848 x 848 pixels. Camera: NIDEK AFC-230. Retinal fundus photograph
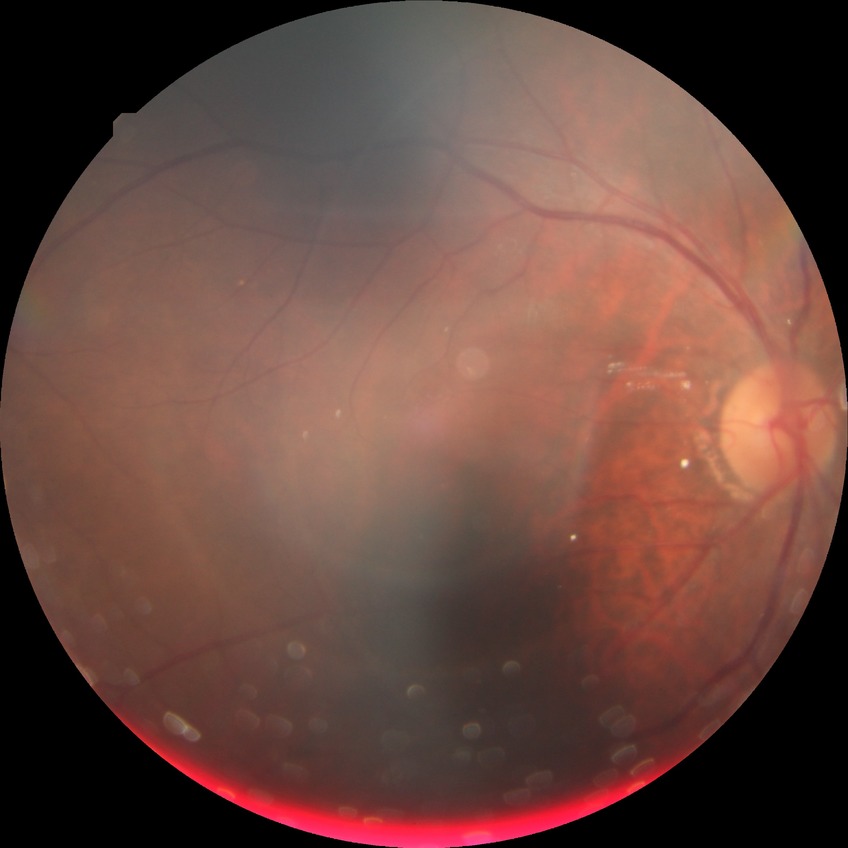
{
  "davis_grade": "no diabetic retinopathy"
}